Captured with the Clarity RetCam 3 (130° field of view); infant wide-field fundus photograph.
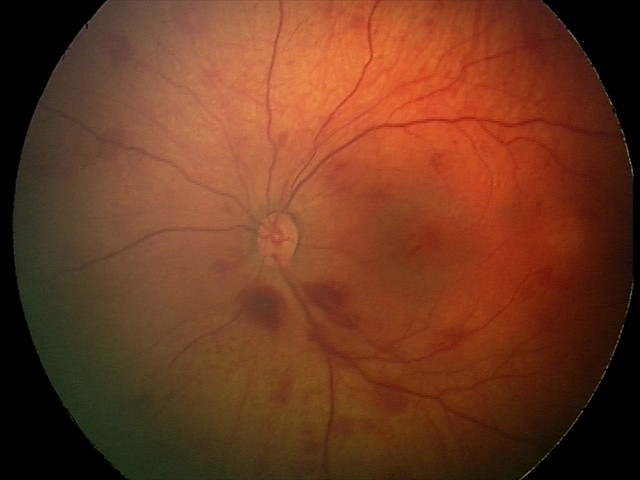
Series diagnosed as retinal hemorrhages.